Pediatric wide-field fundus photograph · 100° field of view (Phoenix ICON).
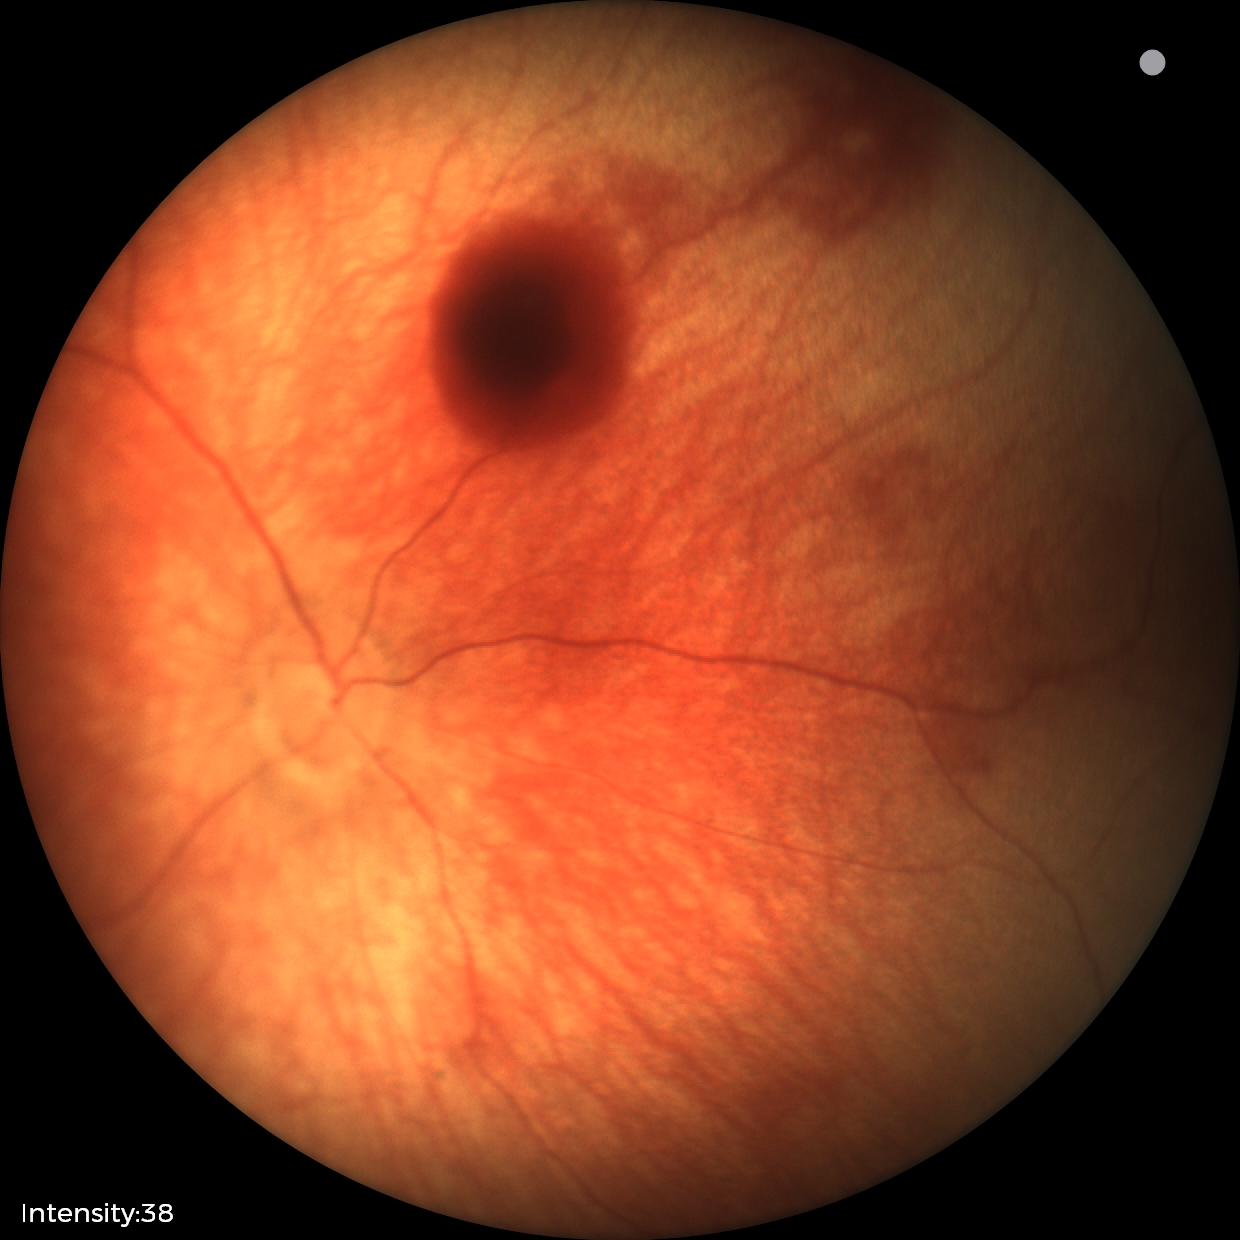

Assessment: retinal hemorrhages.